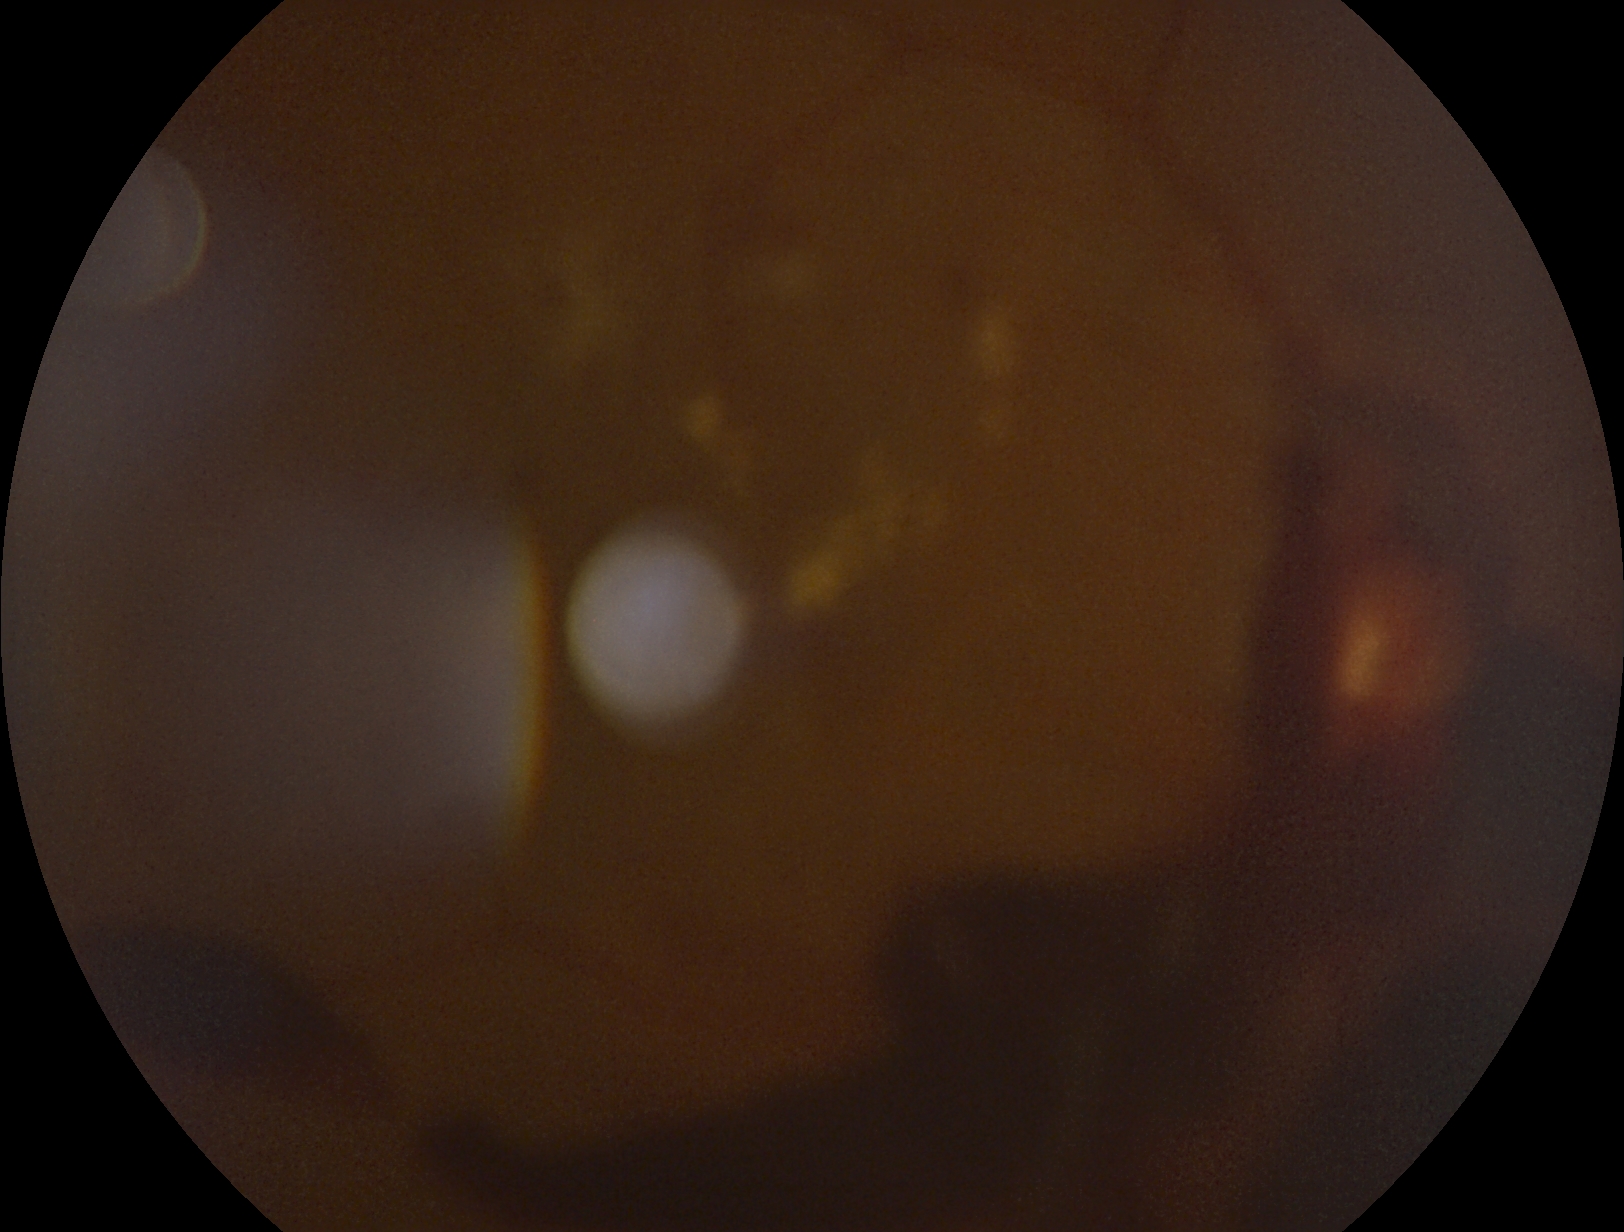

DR class: proliferative diabetic retinopathy.
Diabetic retinopathy (DR): 4.